Infant wide-field fundus photograph:
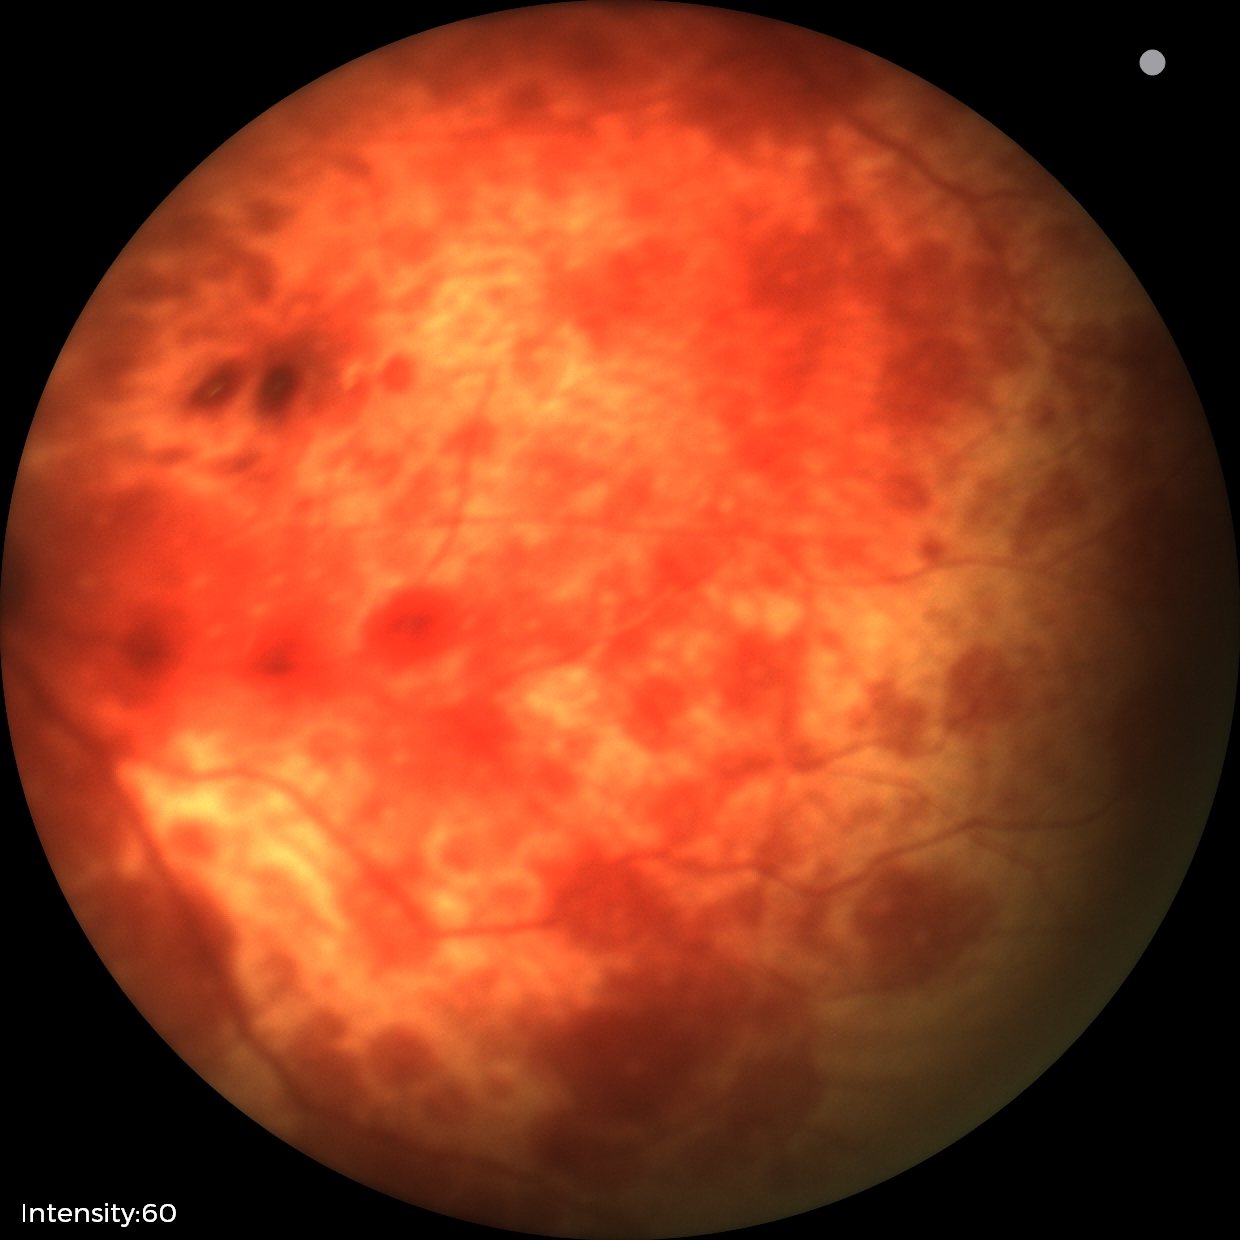
Impression: retinal hemorrhages.